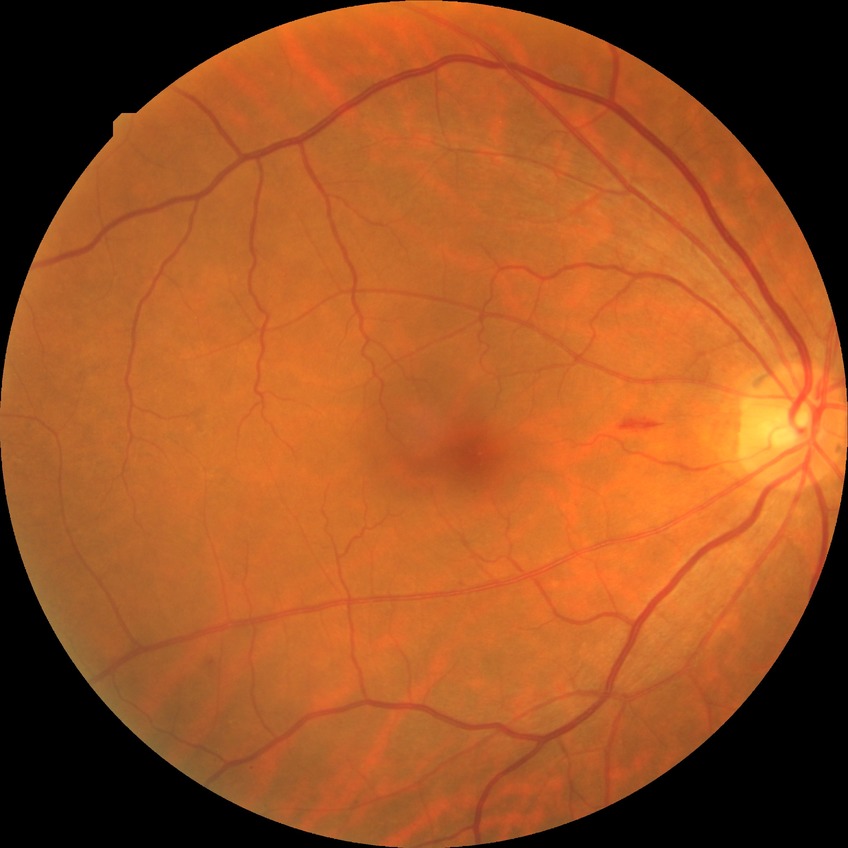
Modified Davis classification: simple diabetic retinopathy.